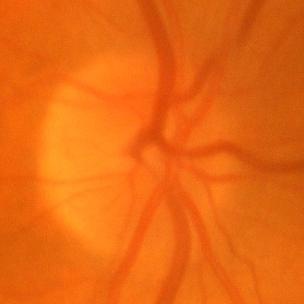
Q: Is there glaucomatous optic neuropathy?
A: No evidence of glaucoma.